Nonmydriatic. 45° field of view — 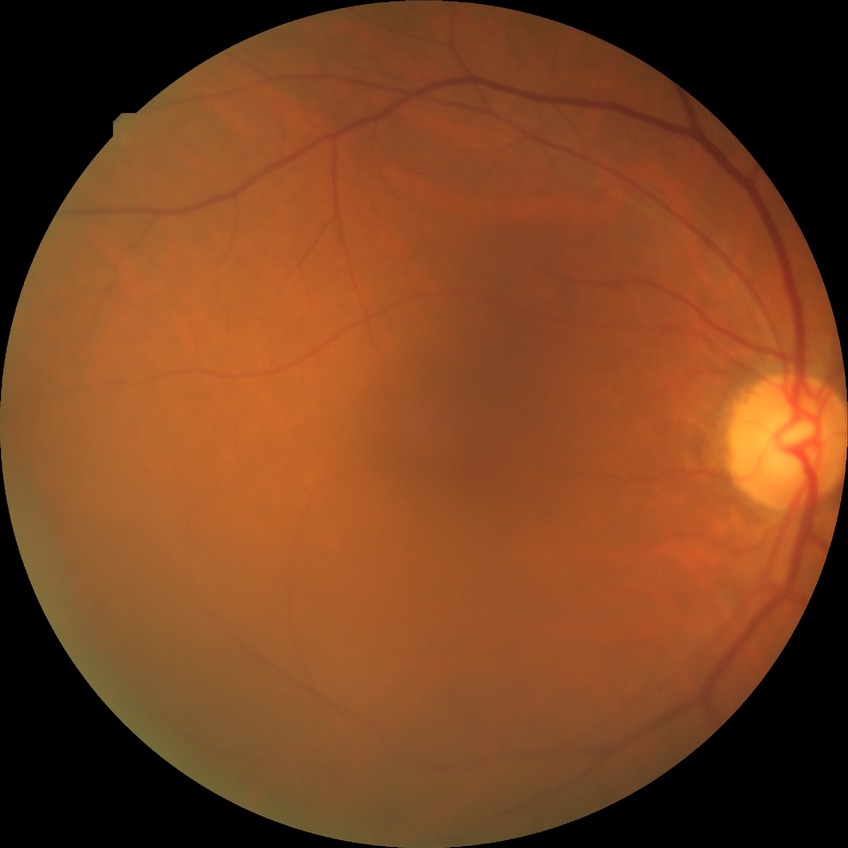 diabetic retinopathy severity = no diabetic retinopathy.